2352 by 1568 pixels:
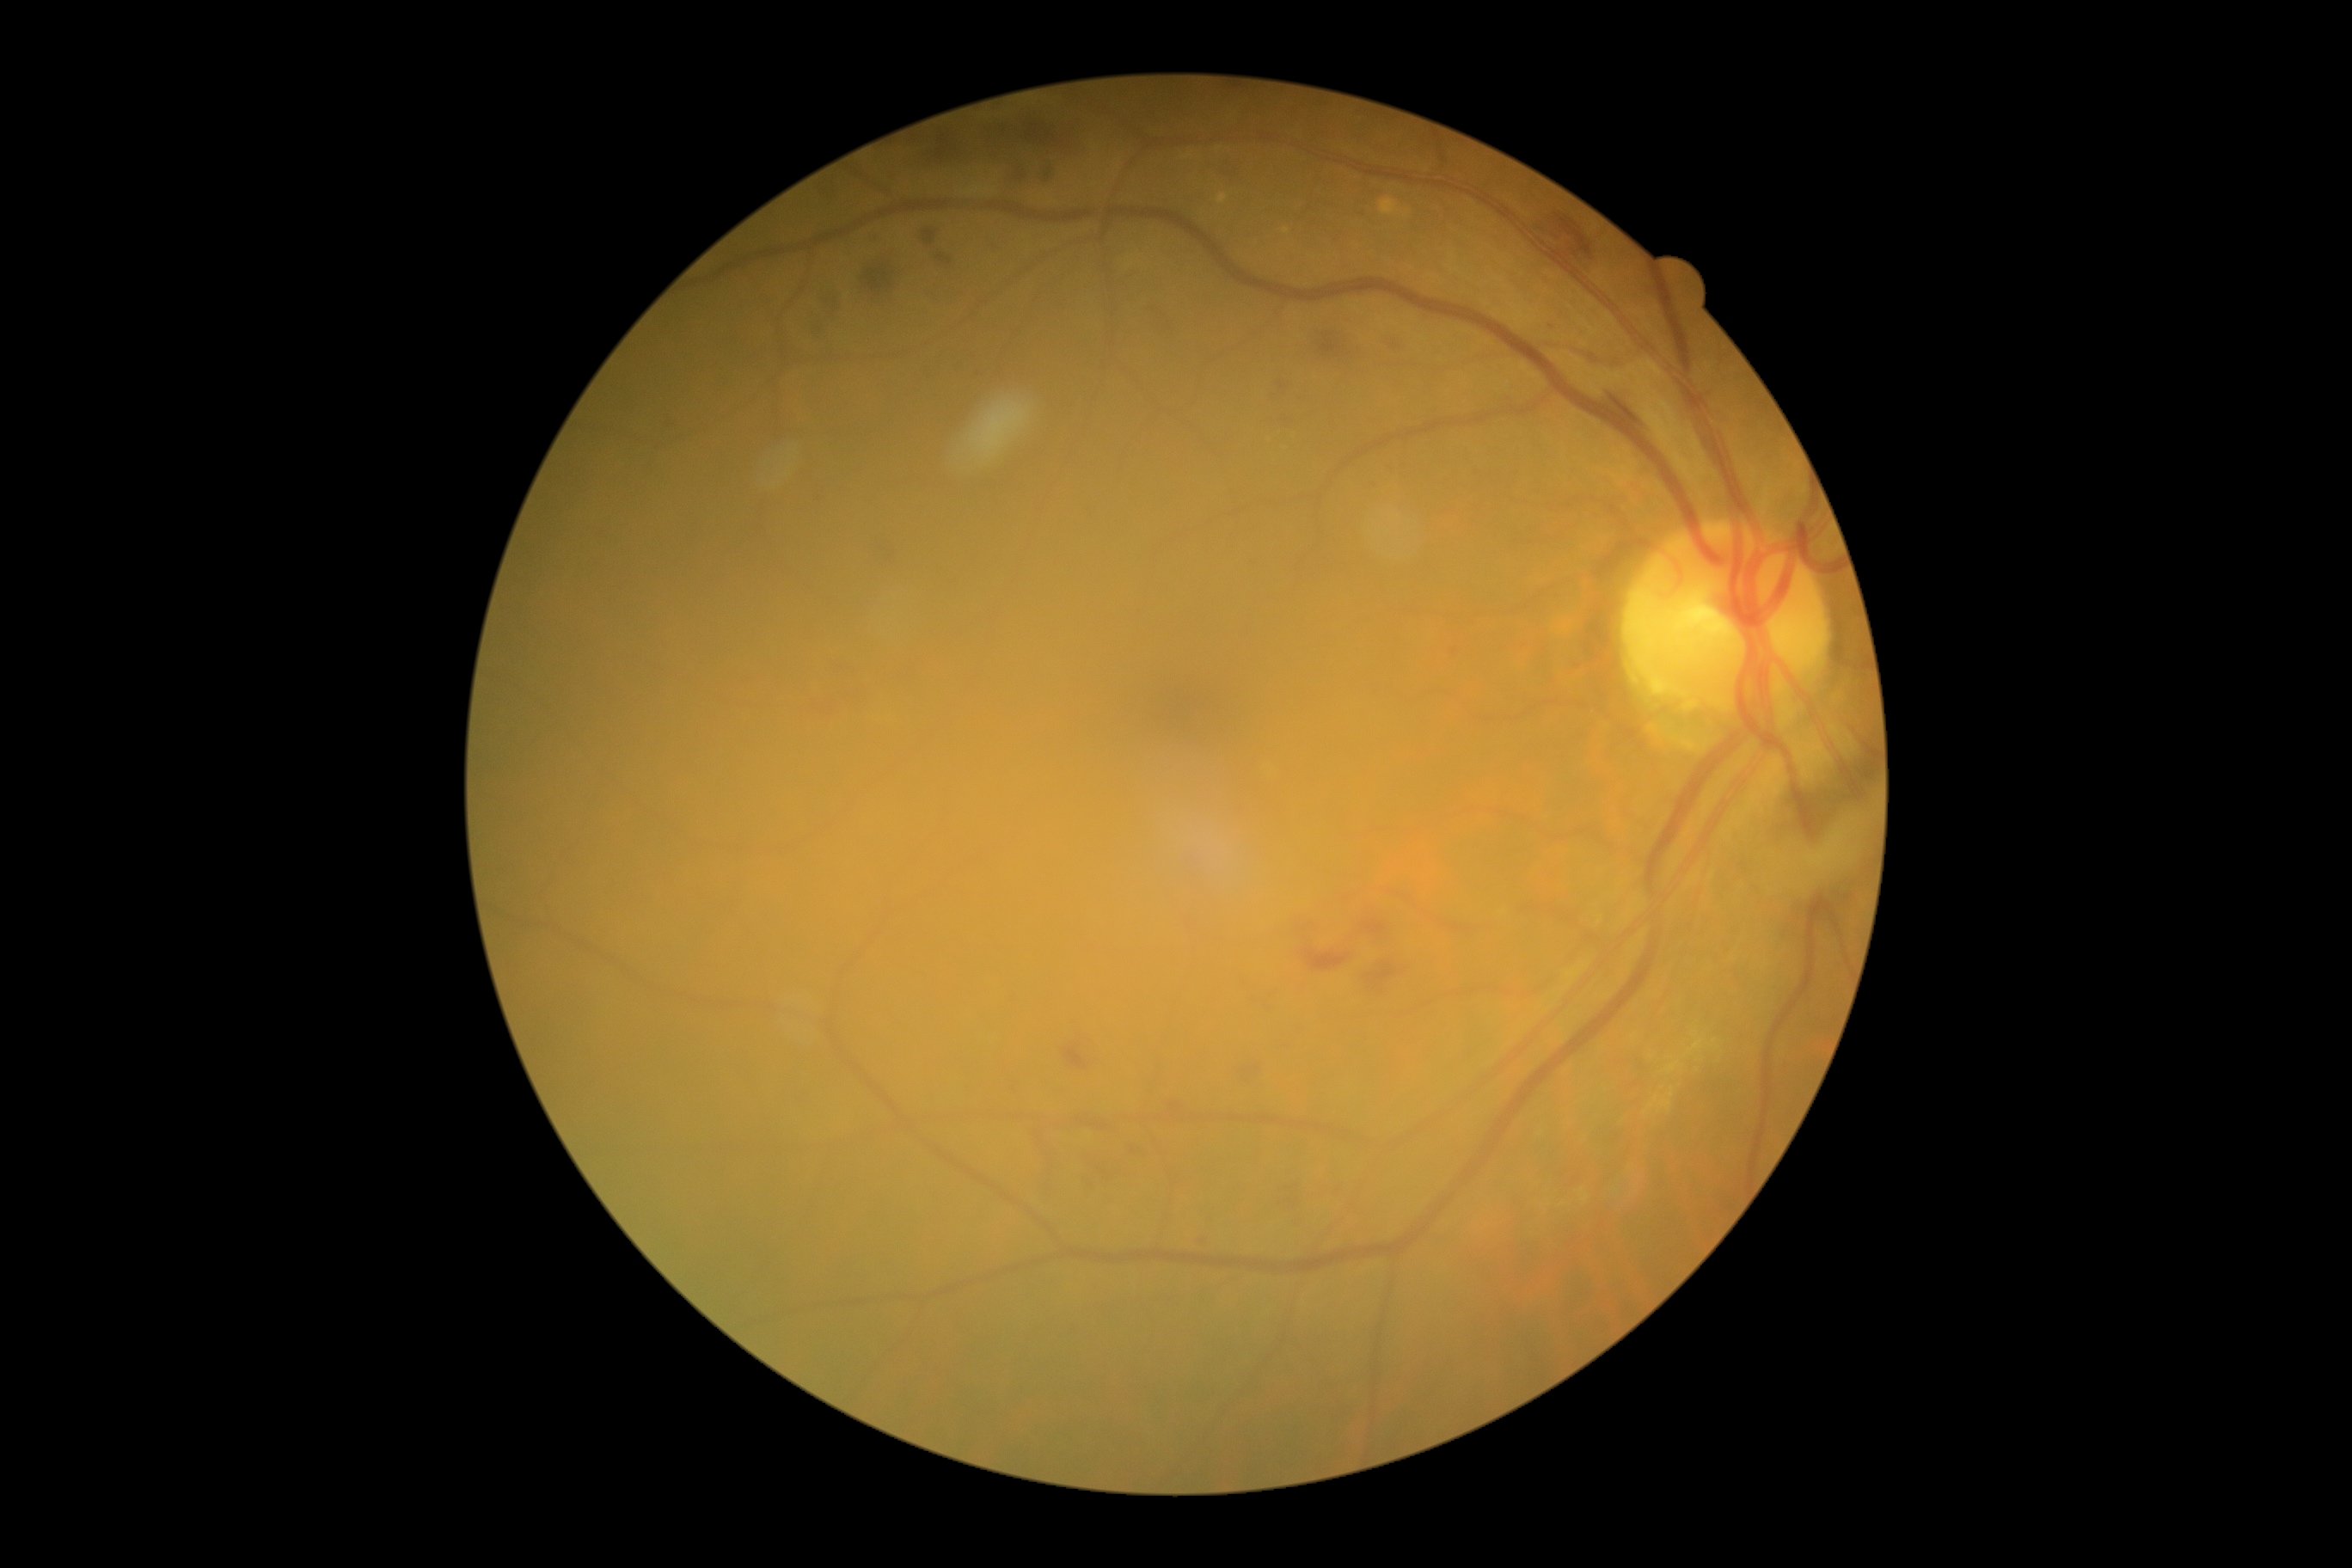 Diabetic retinopathy (DR): moderate NPDR (grade 2)
Representative lesions:
hard exudates (EXs) (subset) = region(1669, 1087, 1675, 1098); region(1581, 1194, 1589, 1201); region(1687, 1039, 1708, 1055); region(1665, 1062, 1681, 1075); region(1648, 1096, 1674, 1112)
EXs (small, approximate centers) near 1713, 1041; 1563, 1205
soft exudates (SEs) = region(1804, 830, 1846, 871)
hemorrhages (HEs) (subset) = region(745, 677, 756, 683); region(663, 415, 678, 431); region(1266, 415, 1295, 431); region(1607, 391, 1645, 434); region(1197, 1237, 1210, 1247); region(1309, 329, 1366, 371); region(1277, 1180, 1306, 1213); region(1371, 482, 1380, 489); region(1125, 1144, 1149, 1158); region(1292, 907, 1393, 974); region(910, 126, 974, 169); region(821, 293, 842, 321); region(1385, 336, 1407, 355); region(1240, 979, 1277, 1014)
microaneurysms (MAs) = region(1234, 805, 1251, 818); region(1251, 561, 1259, 568); region(1356, 211, 1366, 217)
MAs (small, approximate centers) near 1551, 327; 1472, 623